Acquired with a Nidek AFC-330 · retinal fundus photograph:
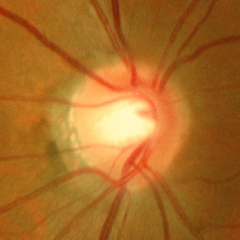

The image shows no signs of glaucoma.